Image size 1924x1556:
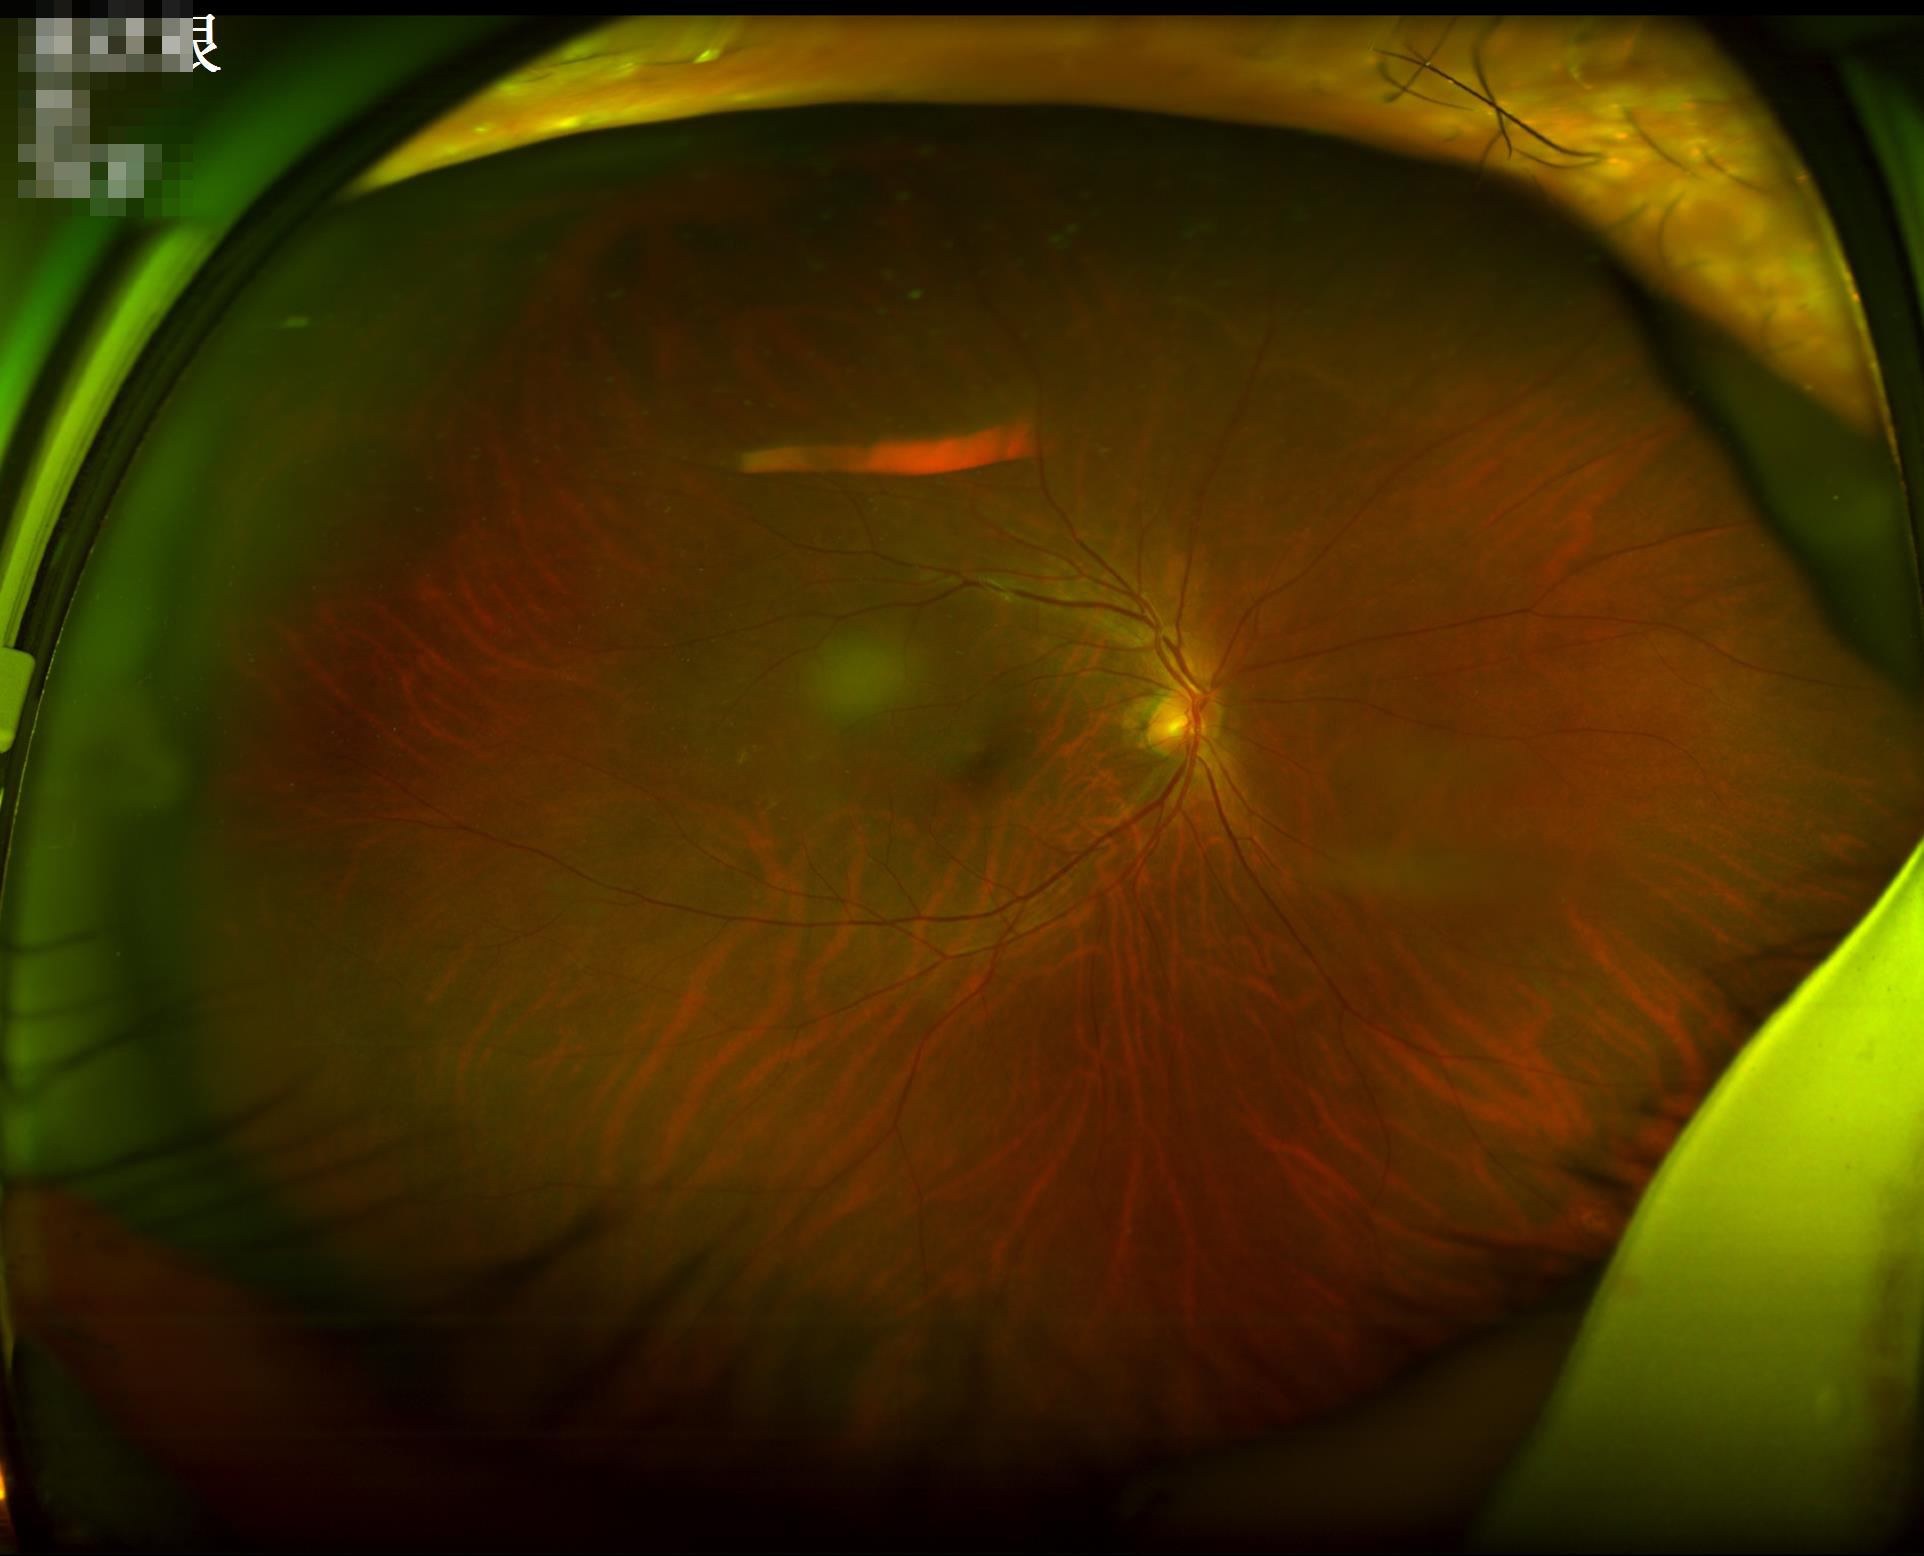

Illumination and color balance are good.
The image is clear.
Overall quality is good and the image is gradable.
Adequate contrast for distinguishing structures.